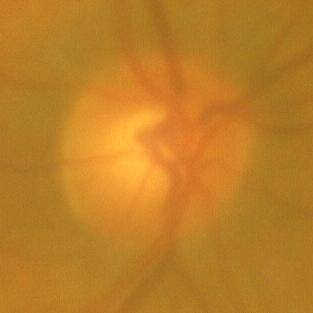

No glaucomatous findings.